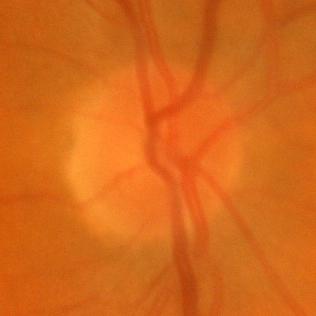

Showing no evidence of glaucoma.